No pharmacologic dilation, retinal fundus photograph.
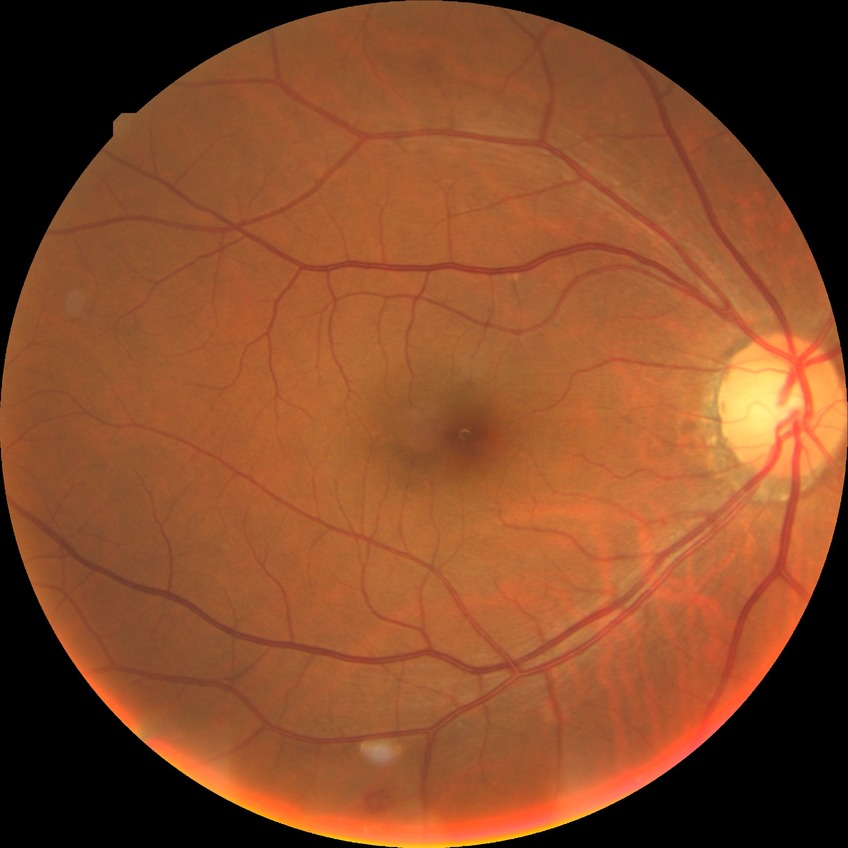
  davis_grade: SDR